240 x 240 pixels, color fundus photograph: 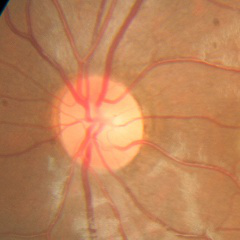
Q: Does this eye have glaucoma?
A: No — no glaucoma.